Infant wide-field fundus photograph; 640x480px — 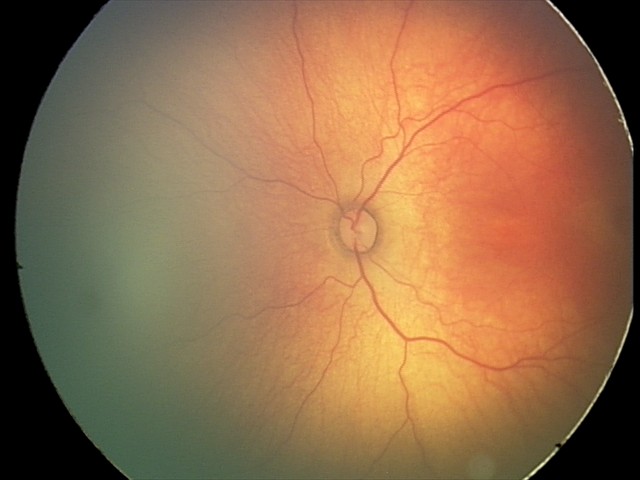
Screening series with status post retinopathy of prematurity.